45° FOV:
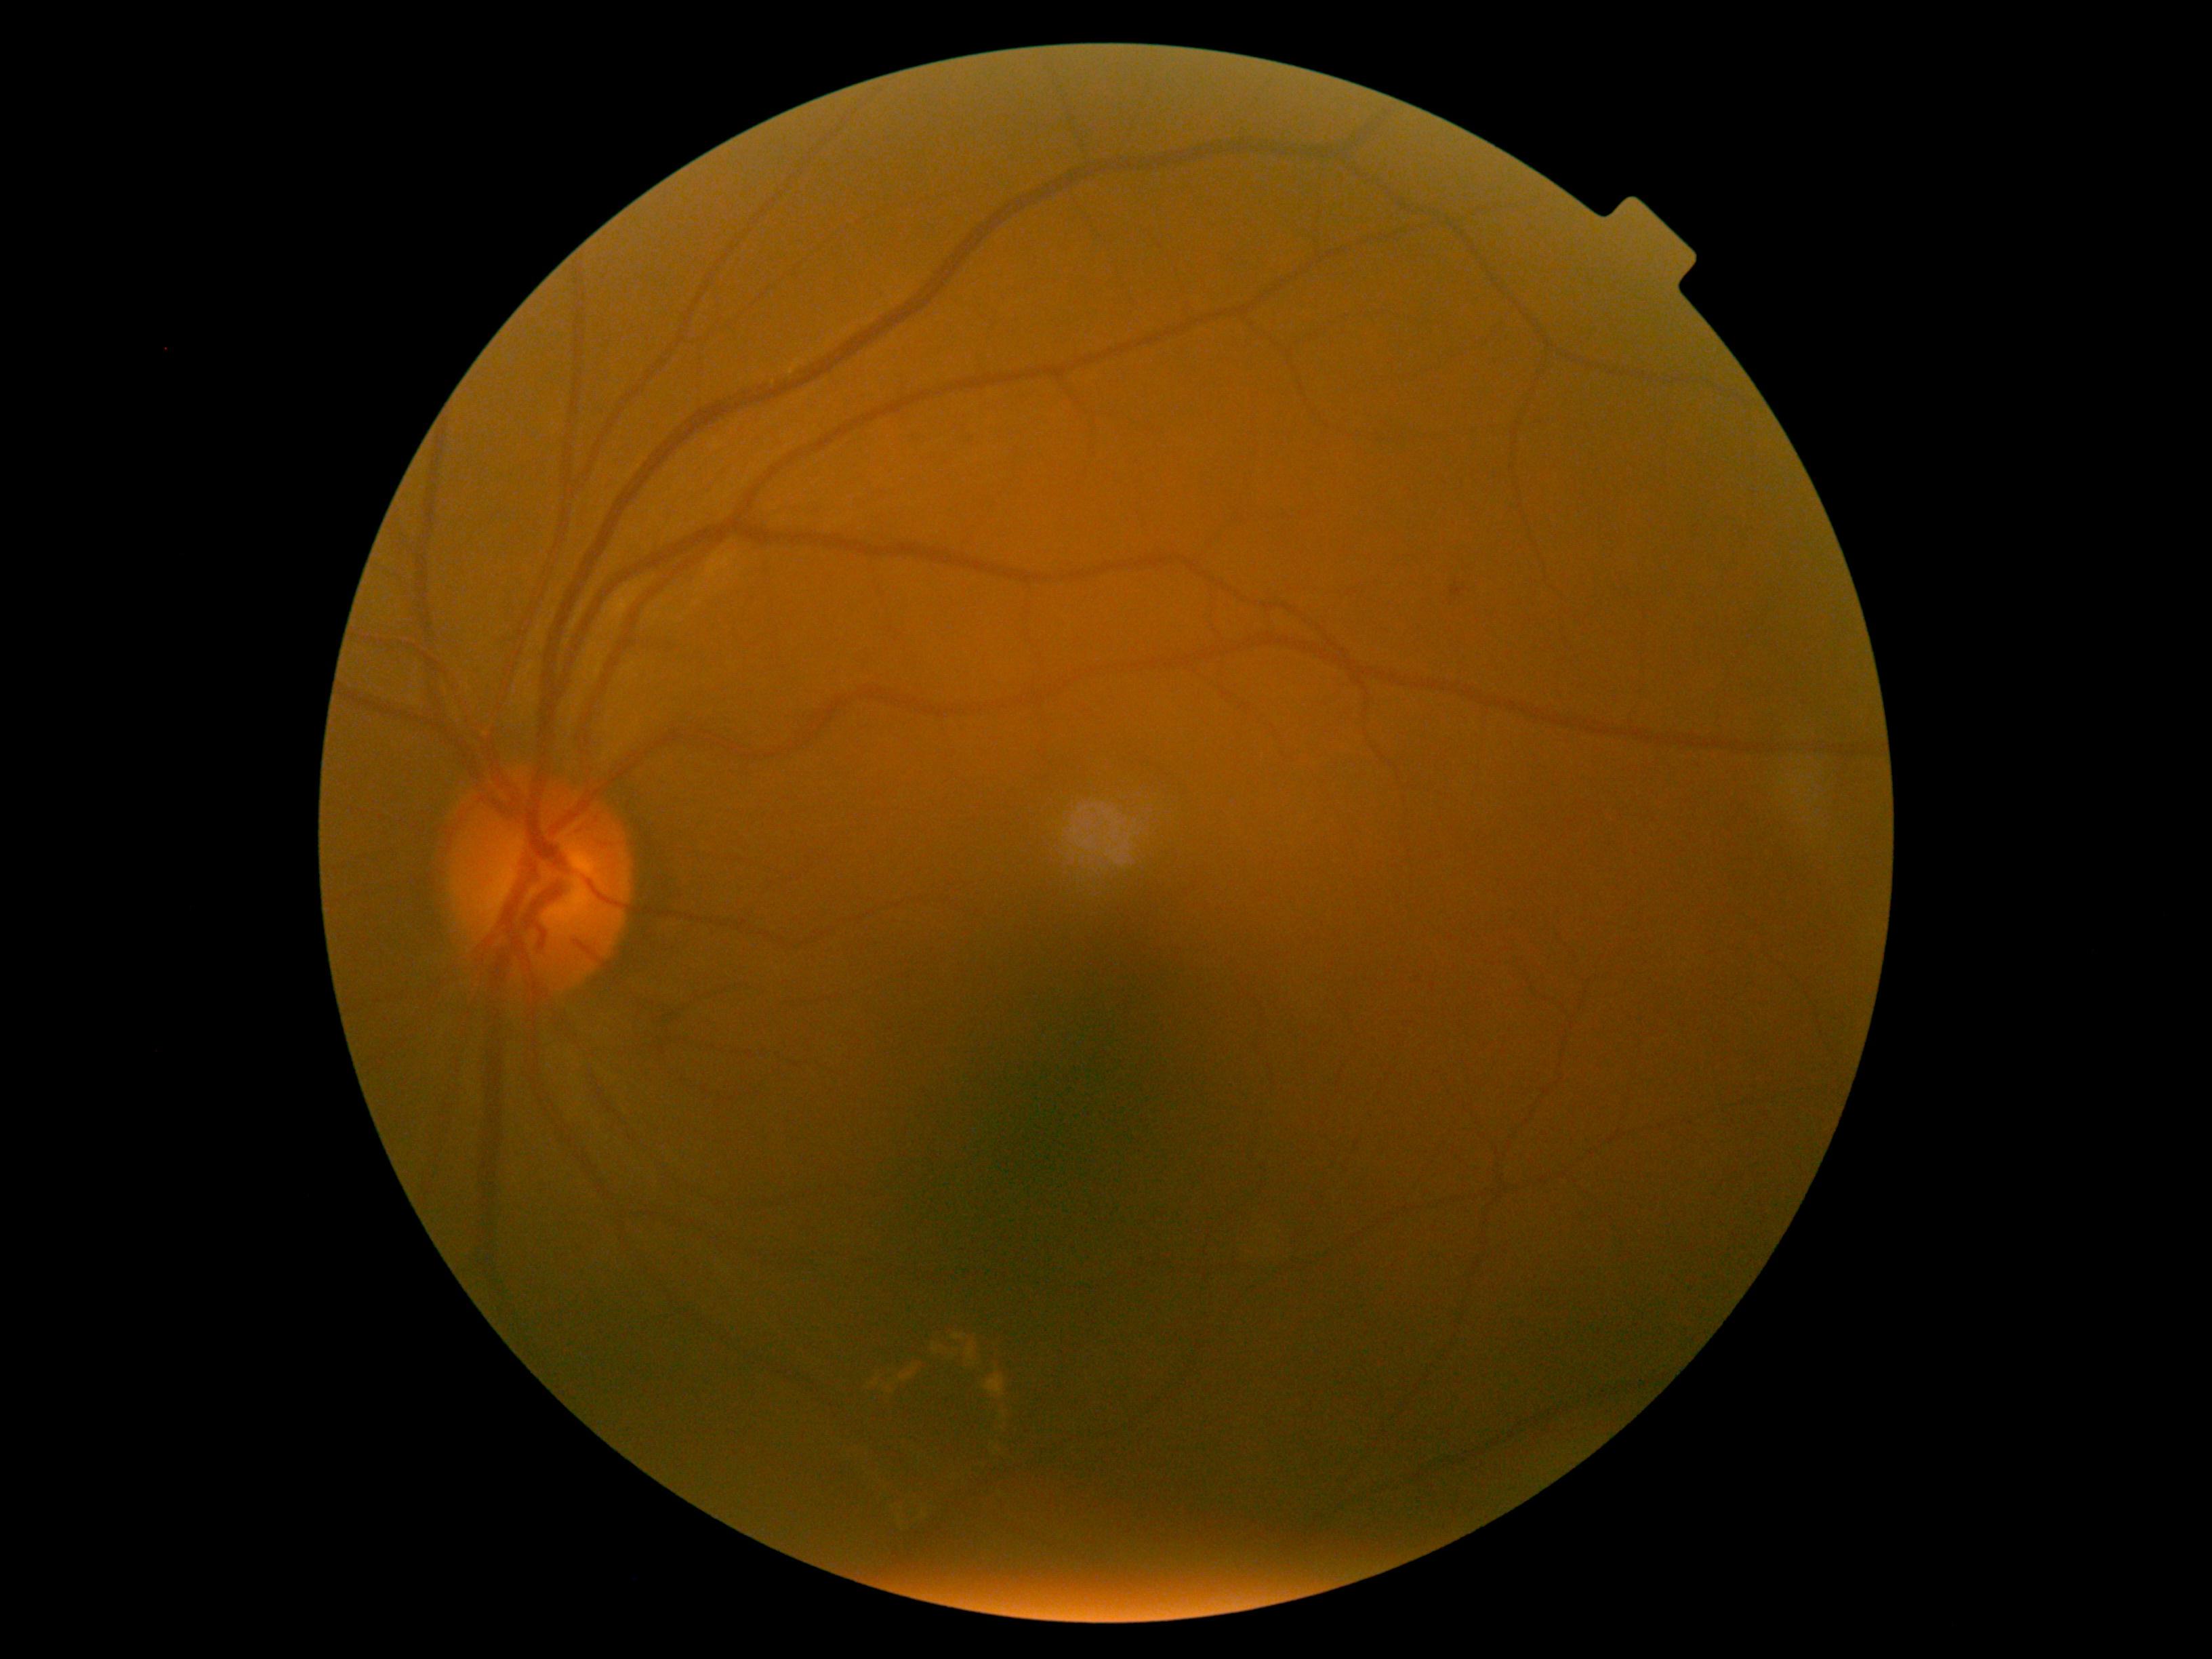
Annotations:
* DR — 2/4 — more than just microaneurysms but less than severe NPDR